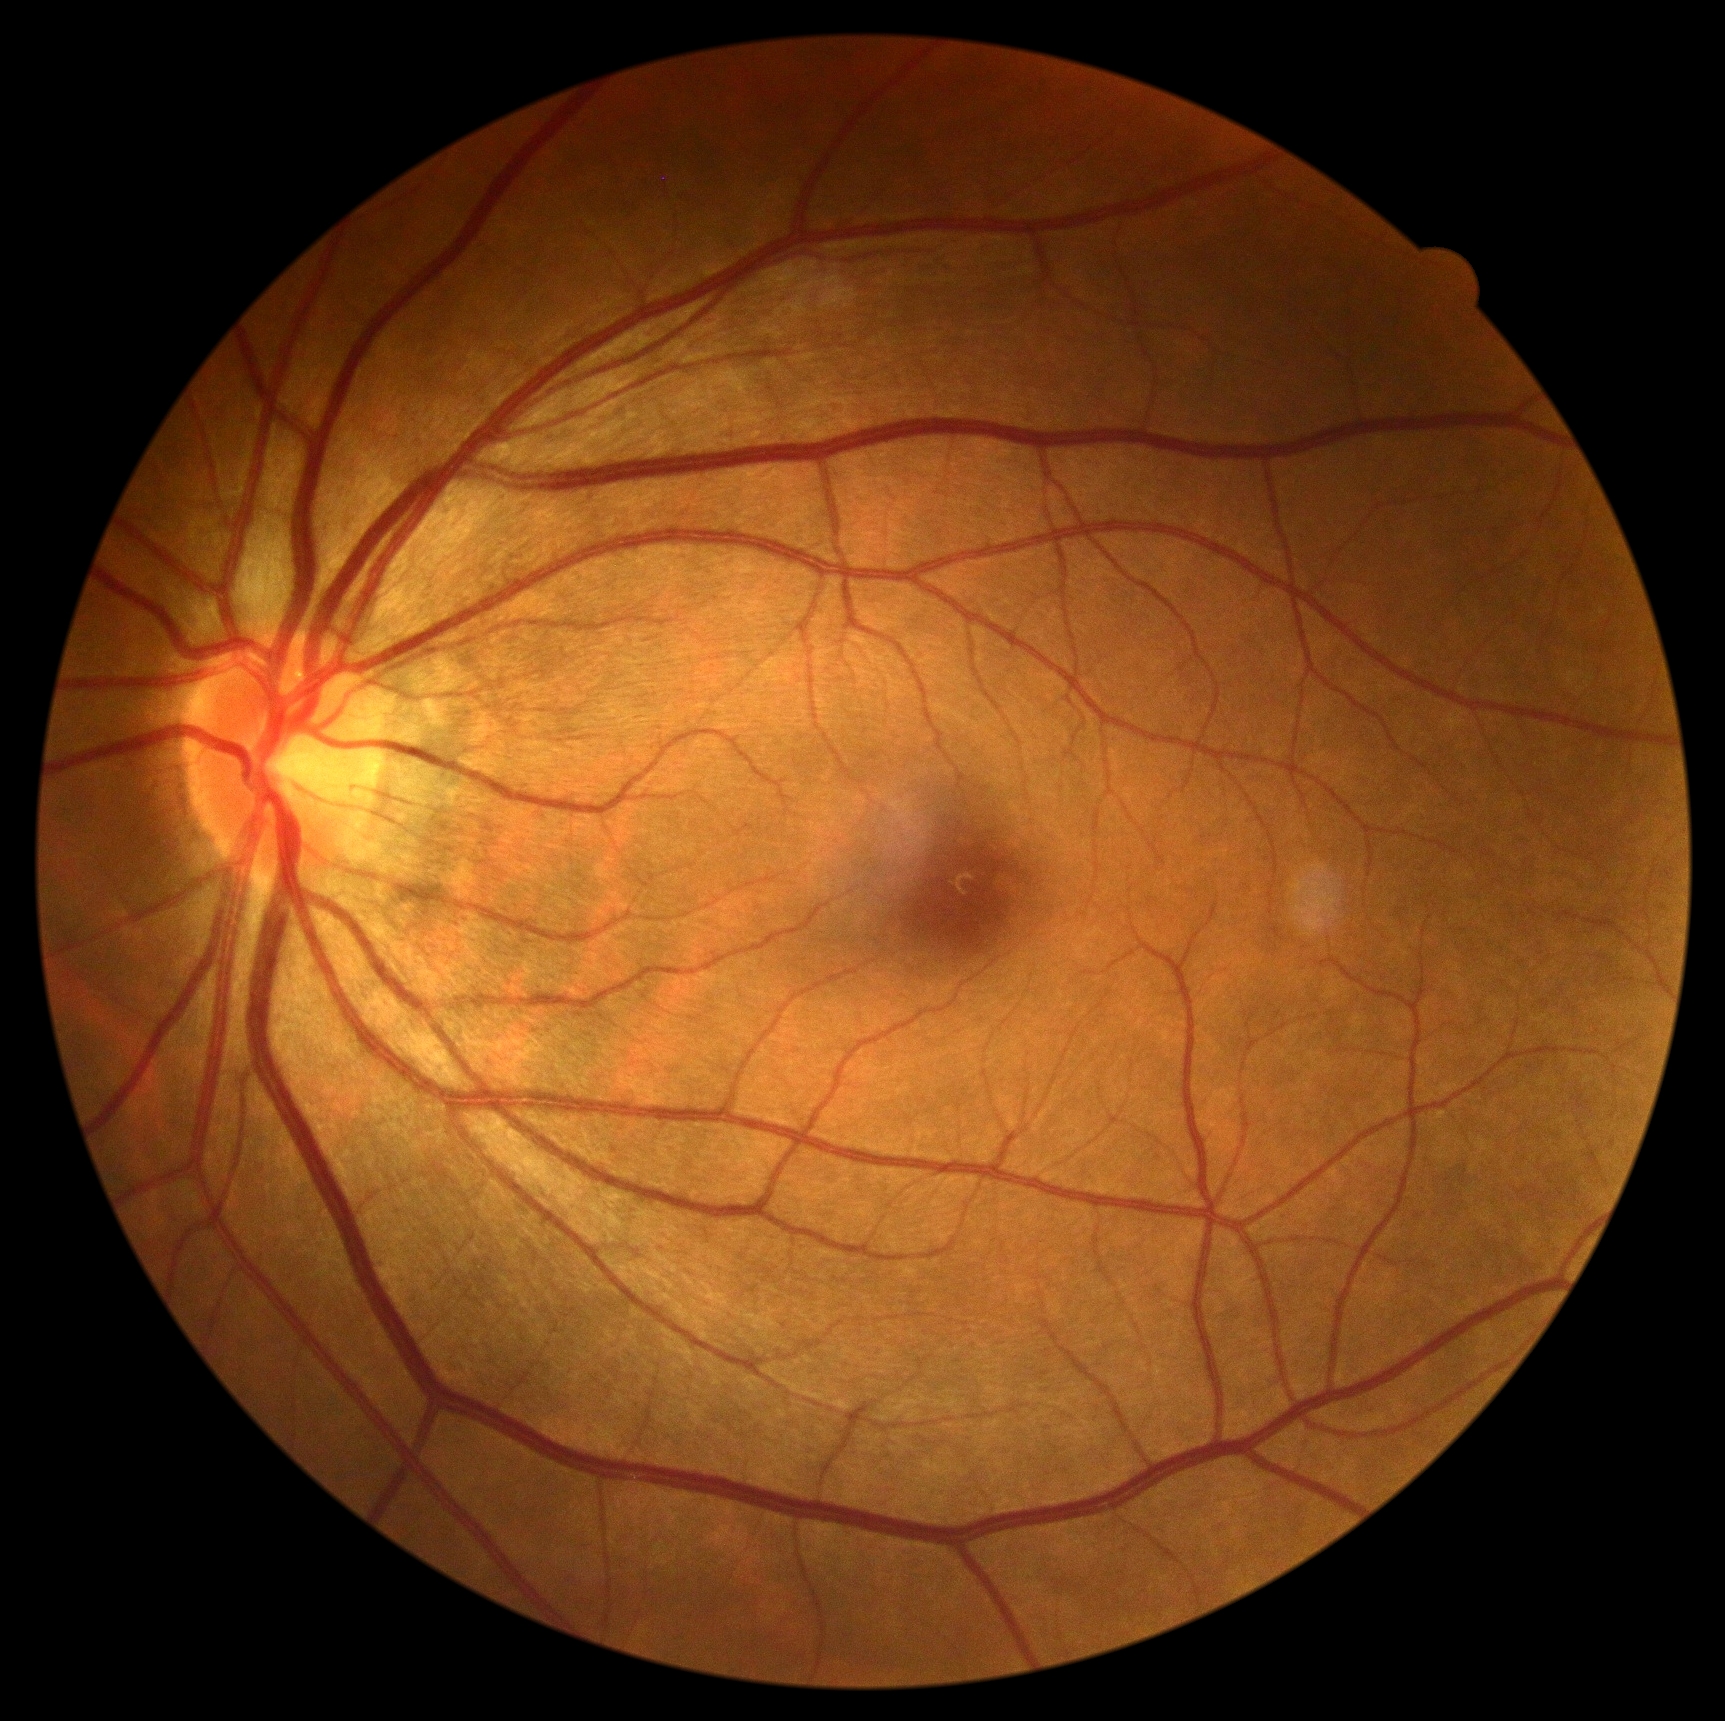
diabetic retinopathy (DR): no apparent diabetic retinopathy (grade 0).